CFP.
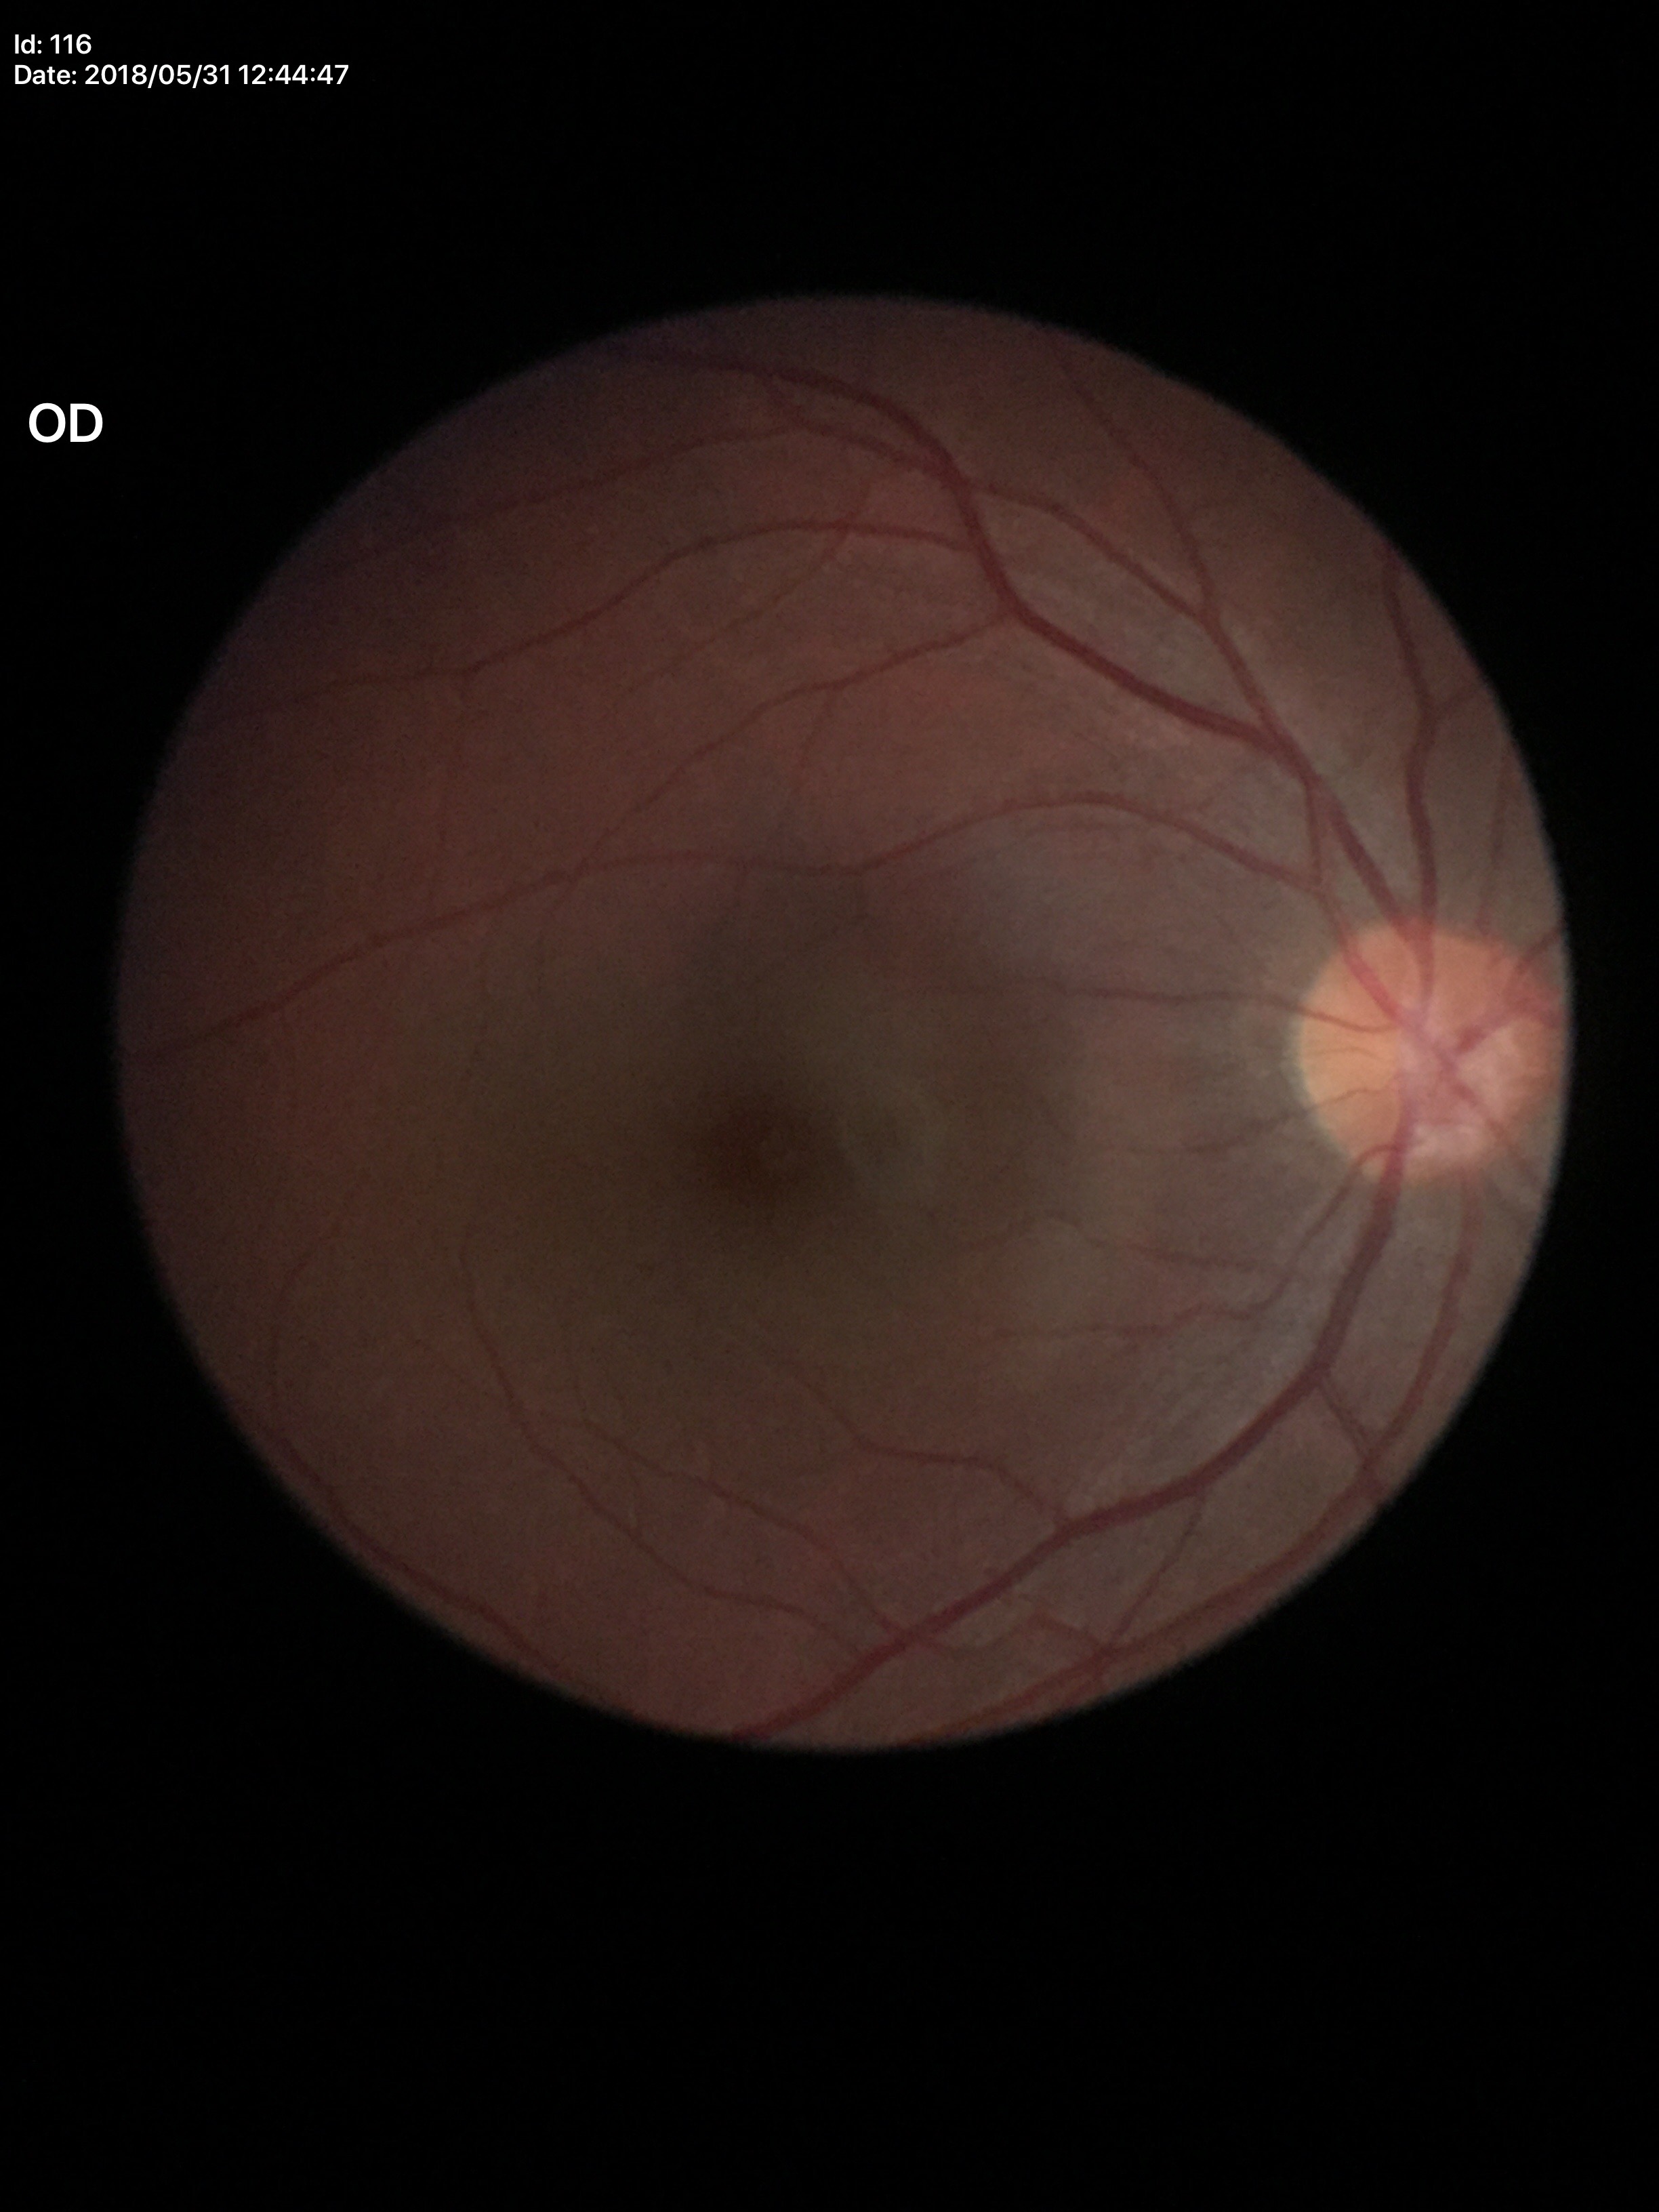

vertical cup-disc ratio: 0.49, horizontal cup-disc ratio: 0.46, Glaucoma screening impression: negative (1/5 graders called glaucoma suspect).